Optic disc region crop. Nidek AFC-330. Non-mydriatic acquisition
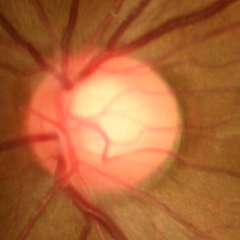 Q: Does this eye have glaucoma?
A: No glaucomatous optic neuropathy.